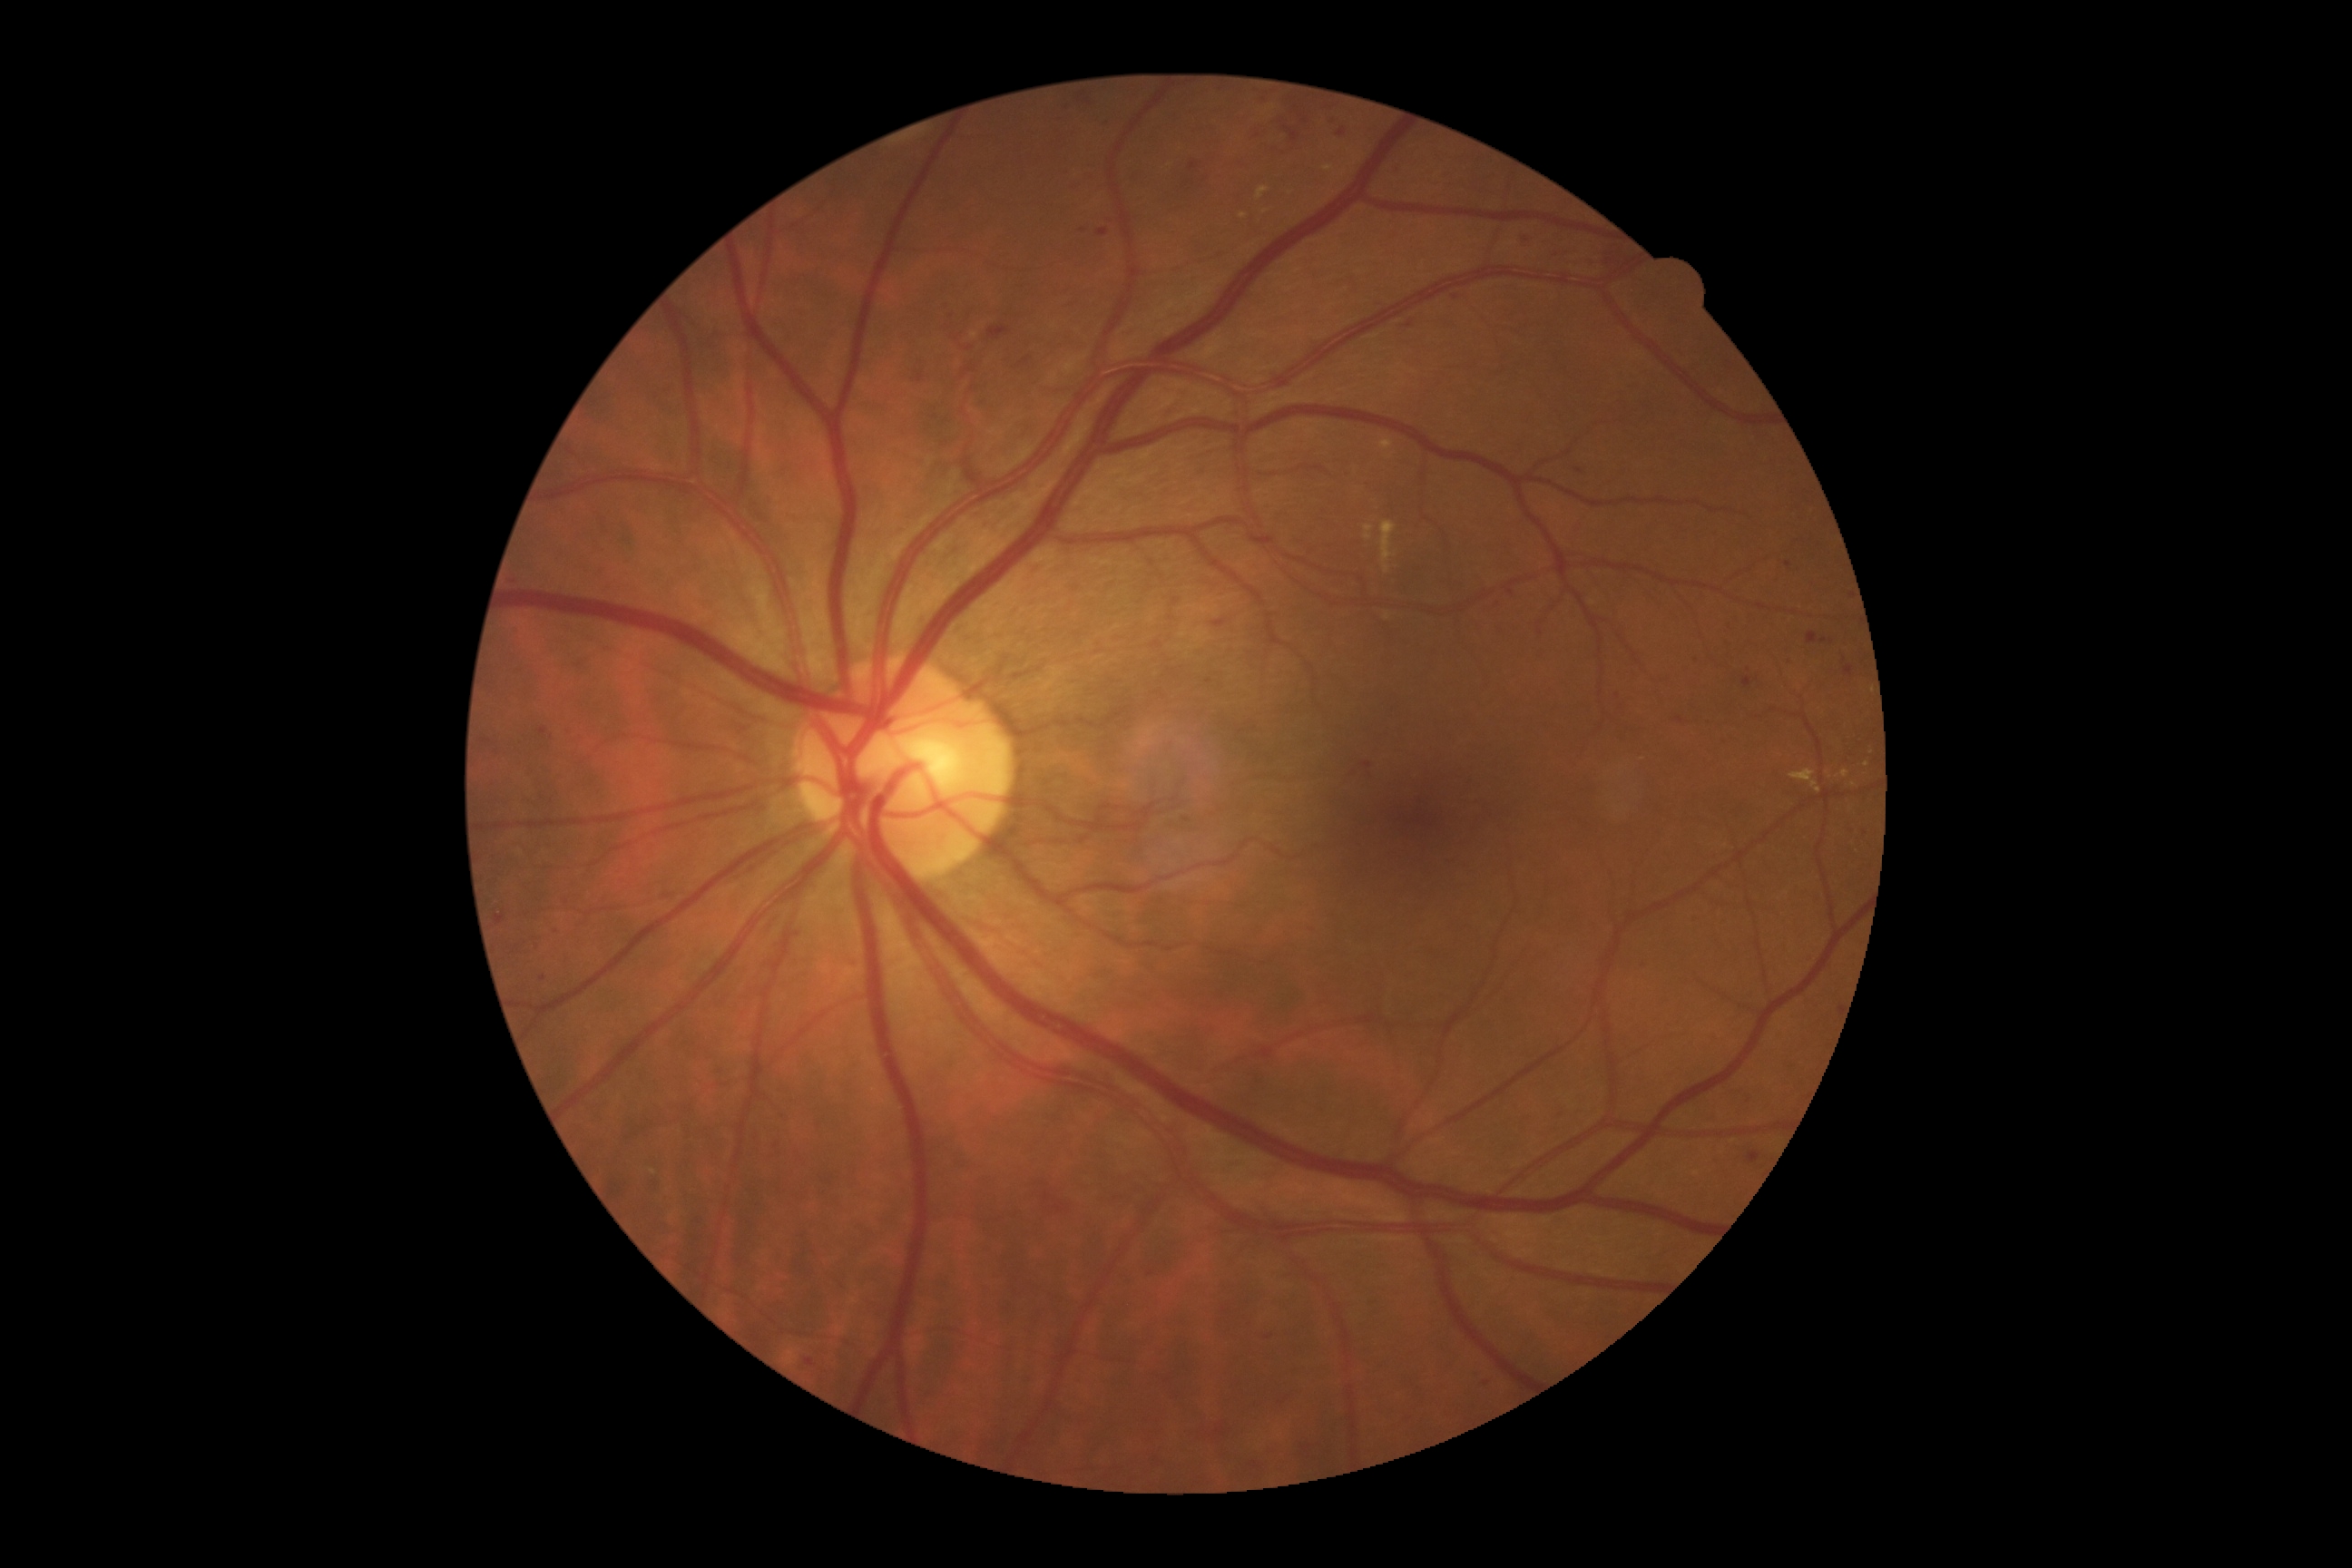
DR grade is 2 (moderate NPDR)
A subset of detected lesions:
HEs (partial) = bbox=[1101, 121, 1112, 130] | bbox=[1636, 959, 1651, 972] | bbox=[963, 368, 975, 378] | bbox=[1250, 124, 1266, 142] | bbox=[1059, 103, 1073, 117] | bbox=[511, 625, 520, 638] | bbox=[1749, 1152, 1761, 1164] | bbox=[790, 926, 805, 945] | bbox=[1362, 761, 1373, 769] | bbox=[1602, 250, 1636, 277] | bbox=[1505, 589, 1514, 596] | bbox=[1320, 104, 1338, 128] | bbox=[660, 380, 680, 398] | bbox=[1269, 97, 1313, 146] | bbox=[1097, 230, 1110, 237]
Small HEs approximately at Point(1187, 820) | Point(1579, 471) | Point(1824, 640)